Fundus photo:
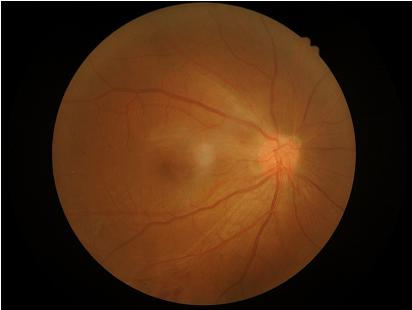
Overall image quality is good. No over- or under-exposure. Adequate contrast for distinguishing structures.